No pharmacologic dilation. 848 by 848 pixels. Retinal fundus photograph. Modified Davis classification. 45-degree field of view. Acquired with a NIDEK AFC-230: 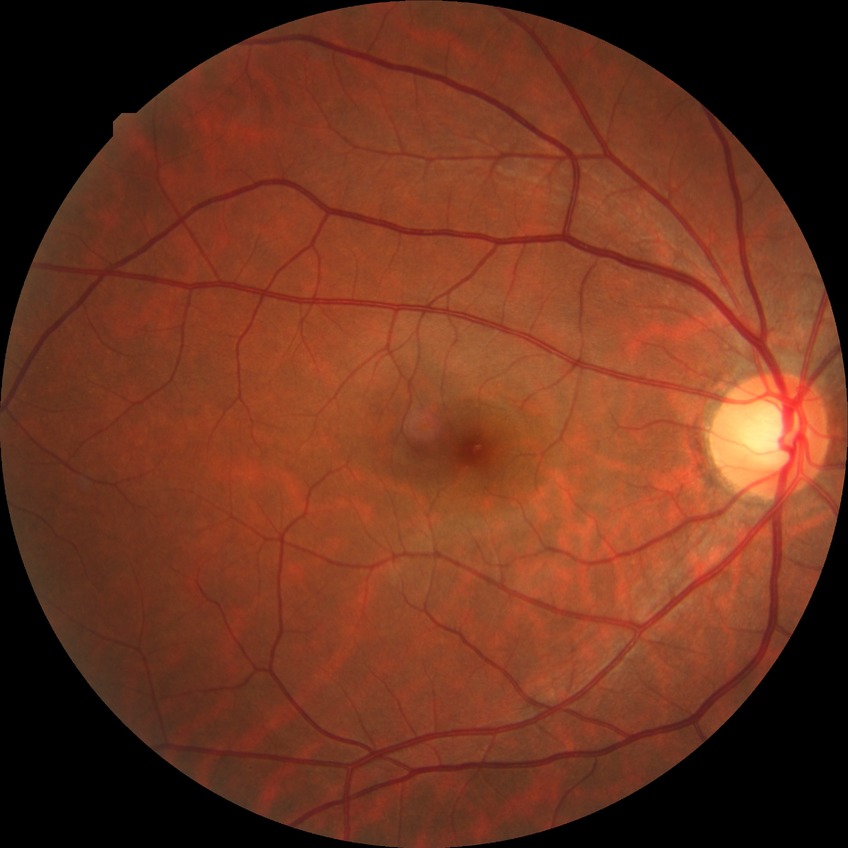
modified Davis classification=no diabetic retinopathy.